Phoenix ICON wide-field infant fundus image · Phoenix ICON, 100° FOV · 1240 x 1240 pixels
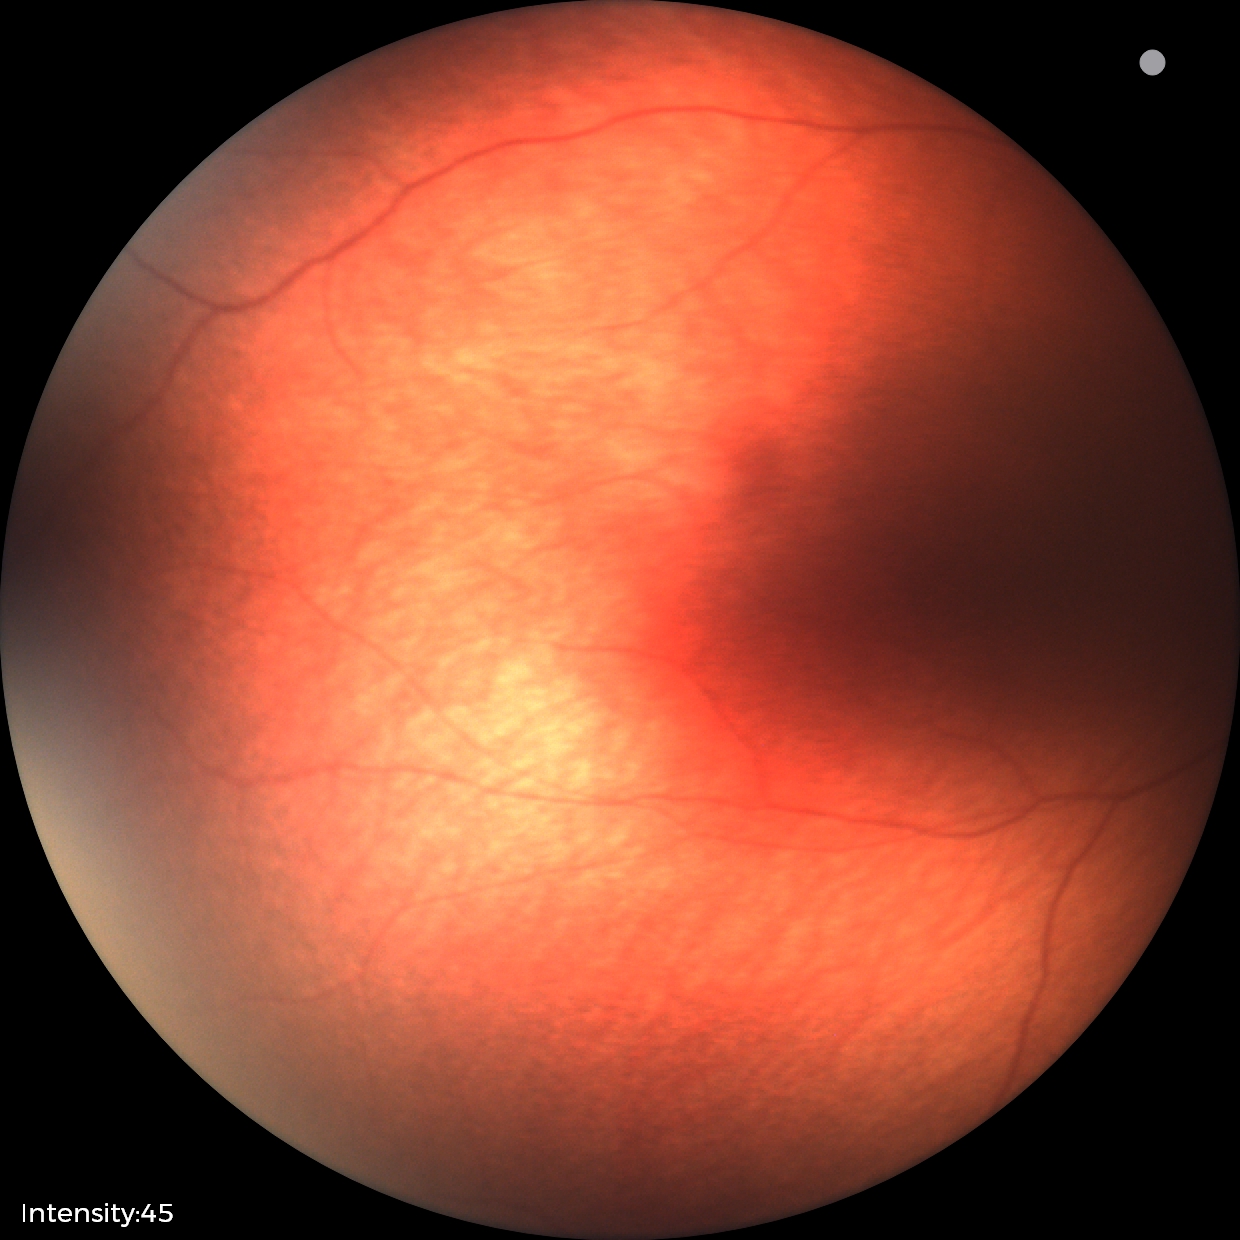
Normal screening examination.